Disc-centered fundus crop — 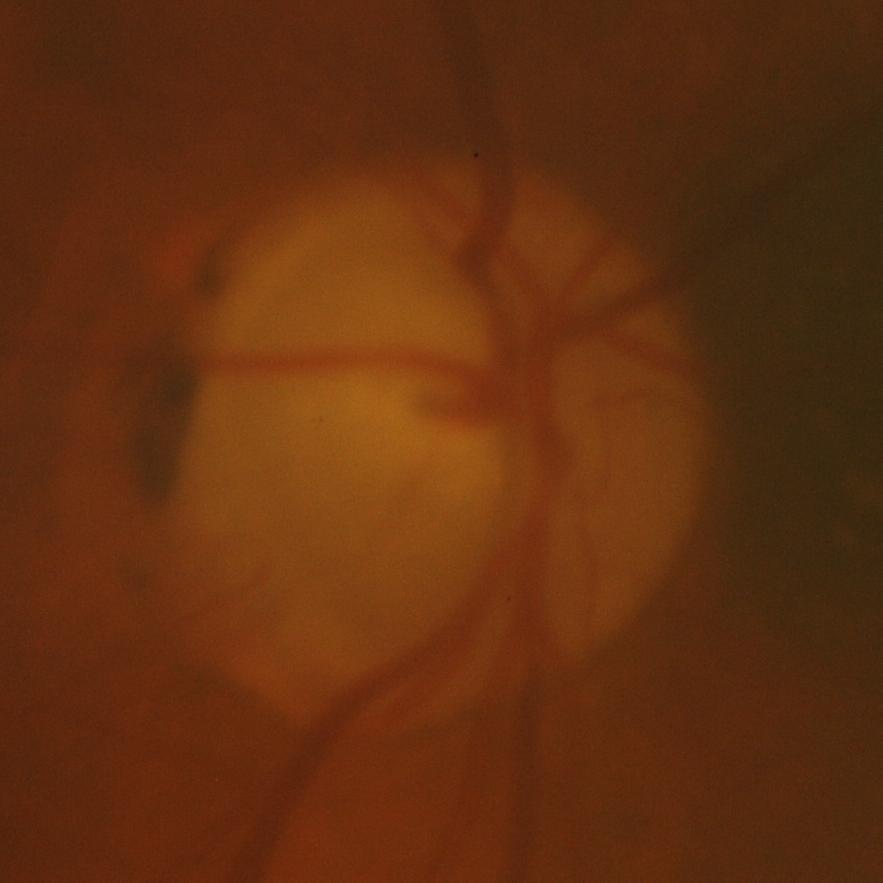

Optic disc appearance consistent with glaucomatous changes.